Diabetic retinopathy graded by the modified Davis classification. Retinal fundus photograph. Camera: NIDEK AFC-230
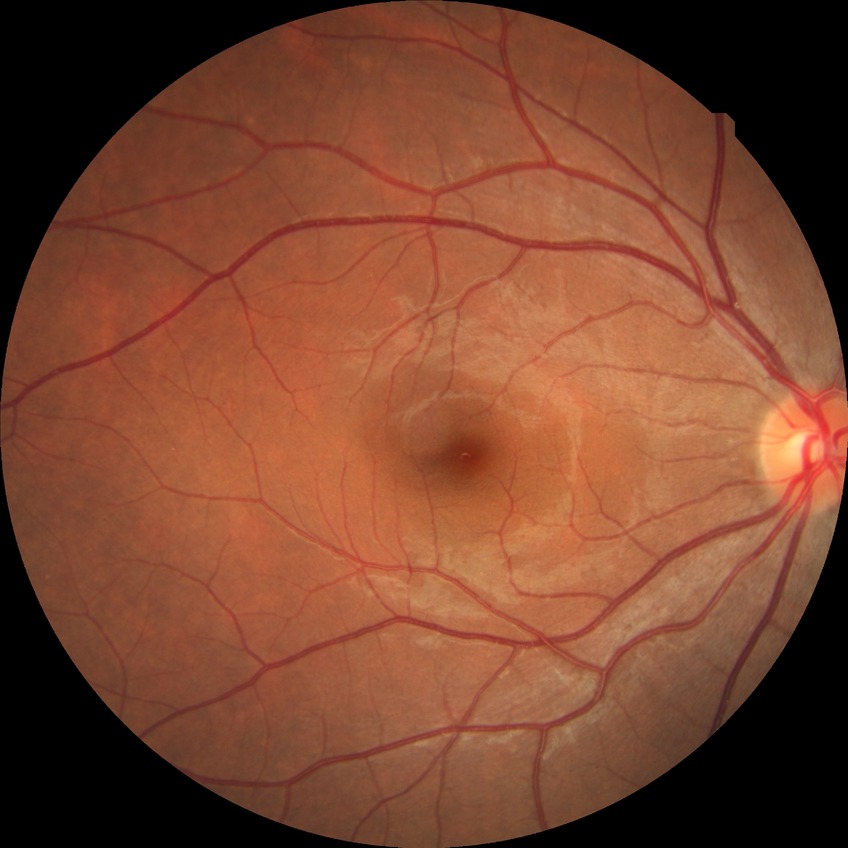

Diabetic retinopathy (DR): NDR (no diabetic retinopathy).